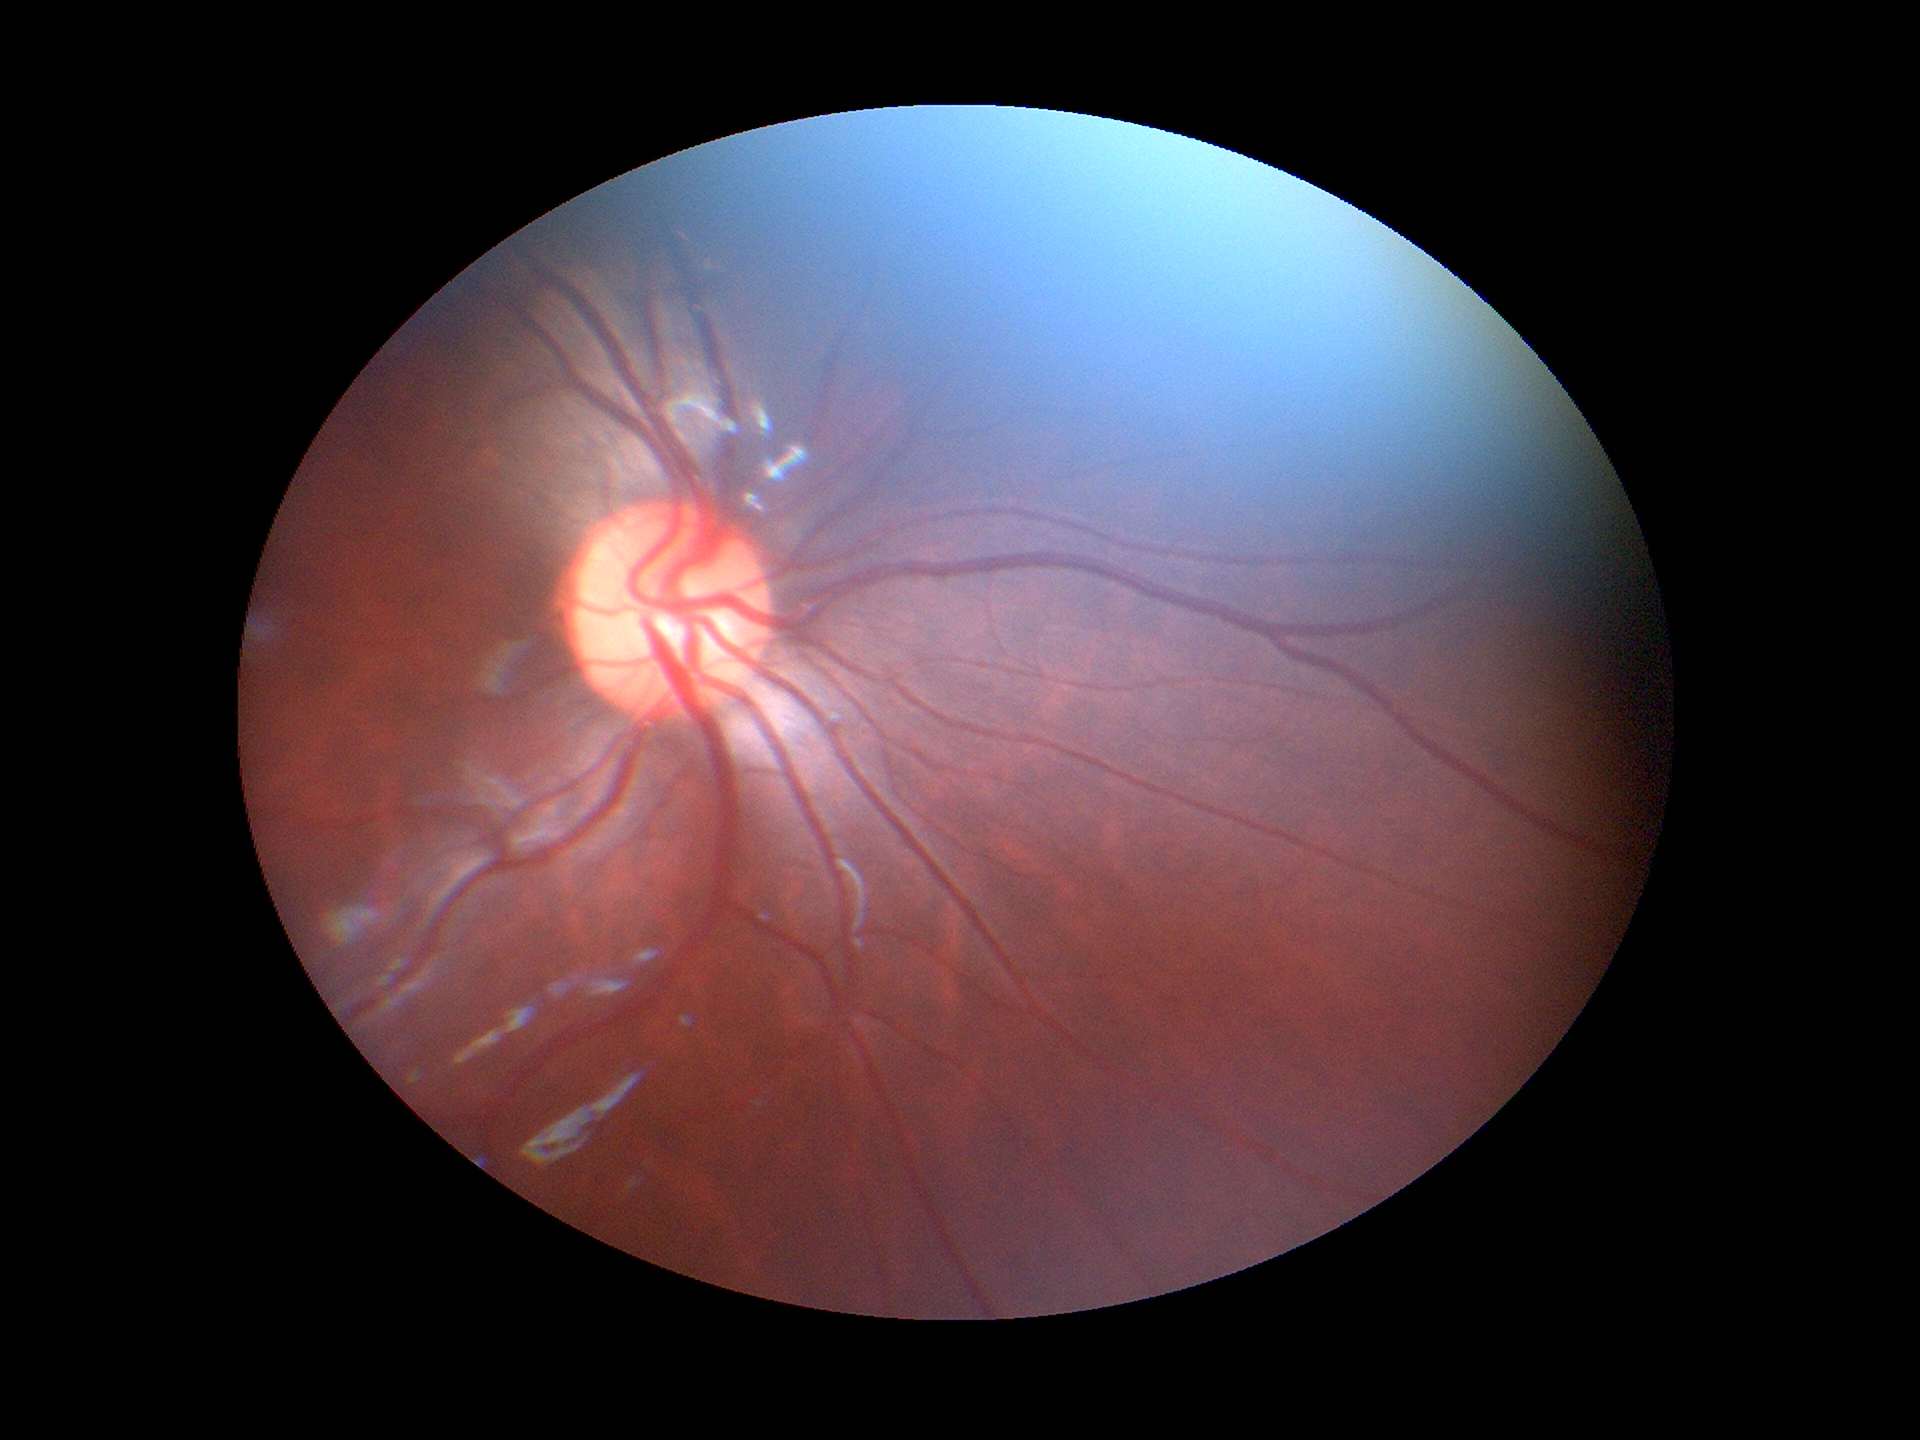

No evidence of glaucoma.
Vertical cup-disc ratio (VCDR): 0.52.